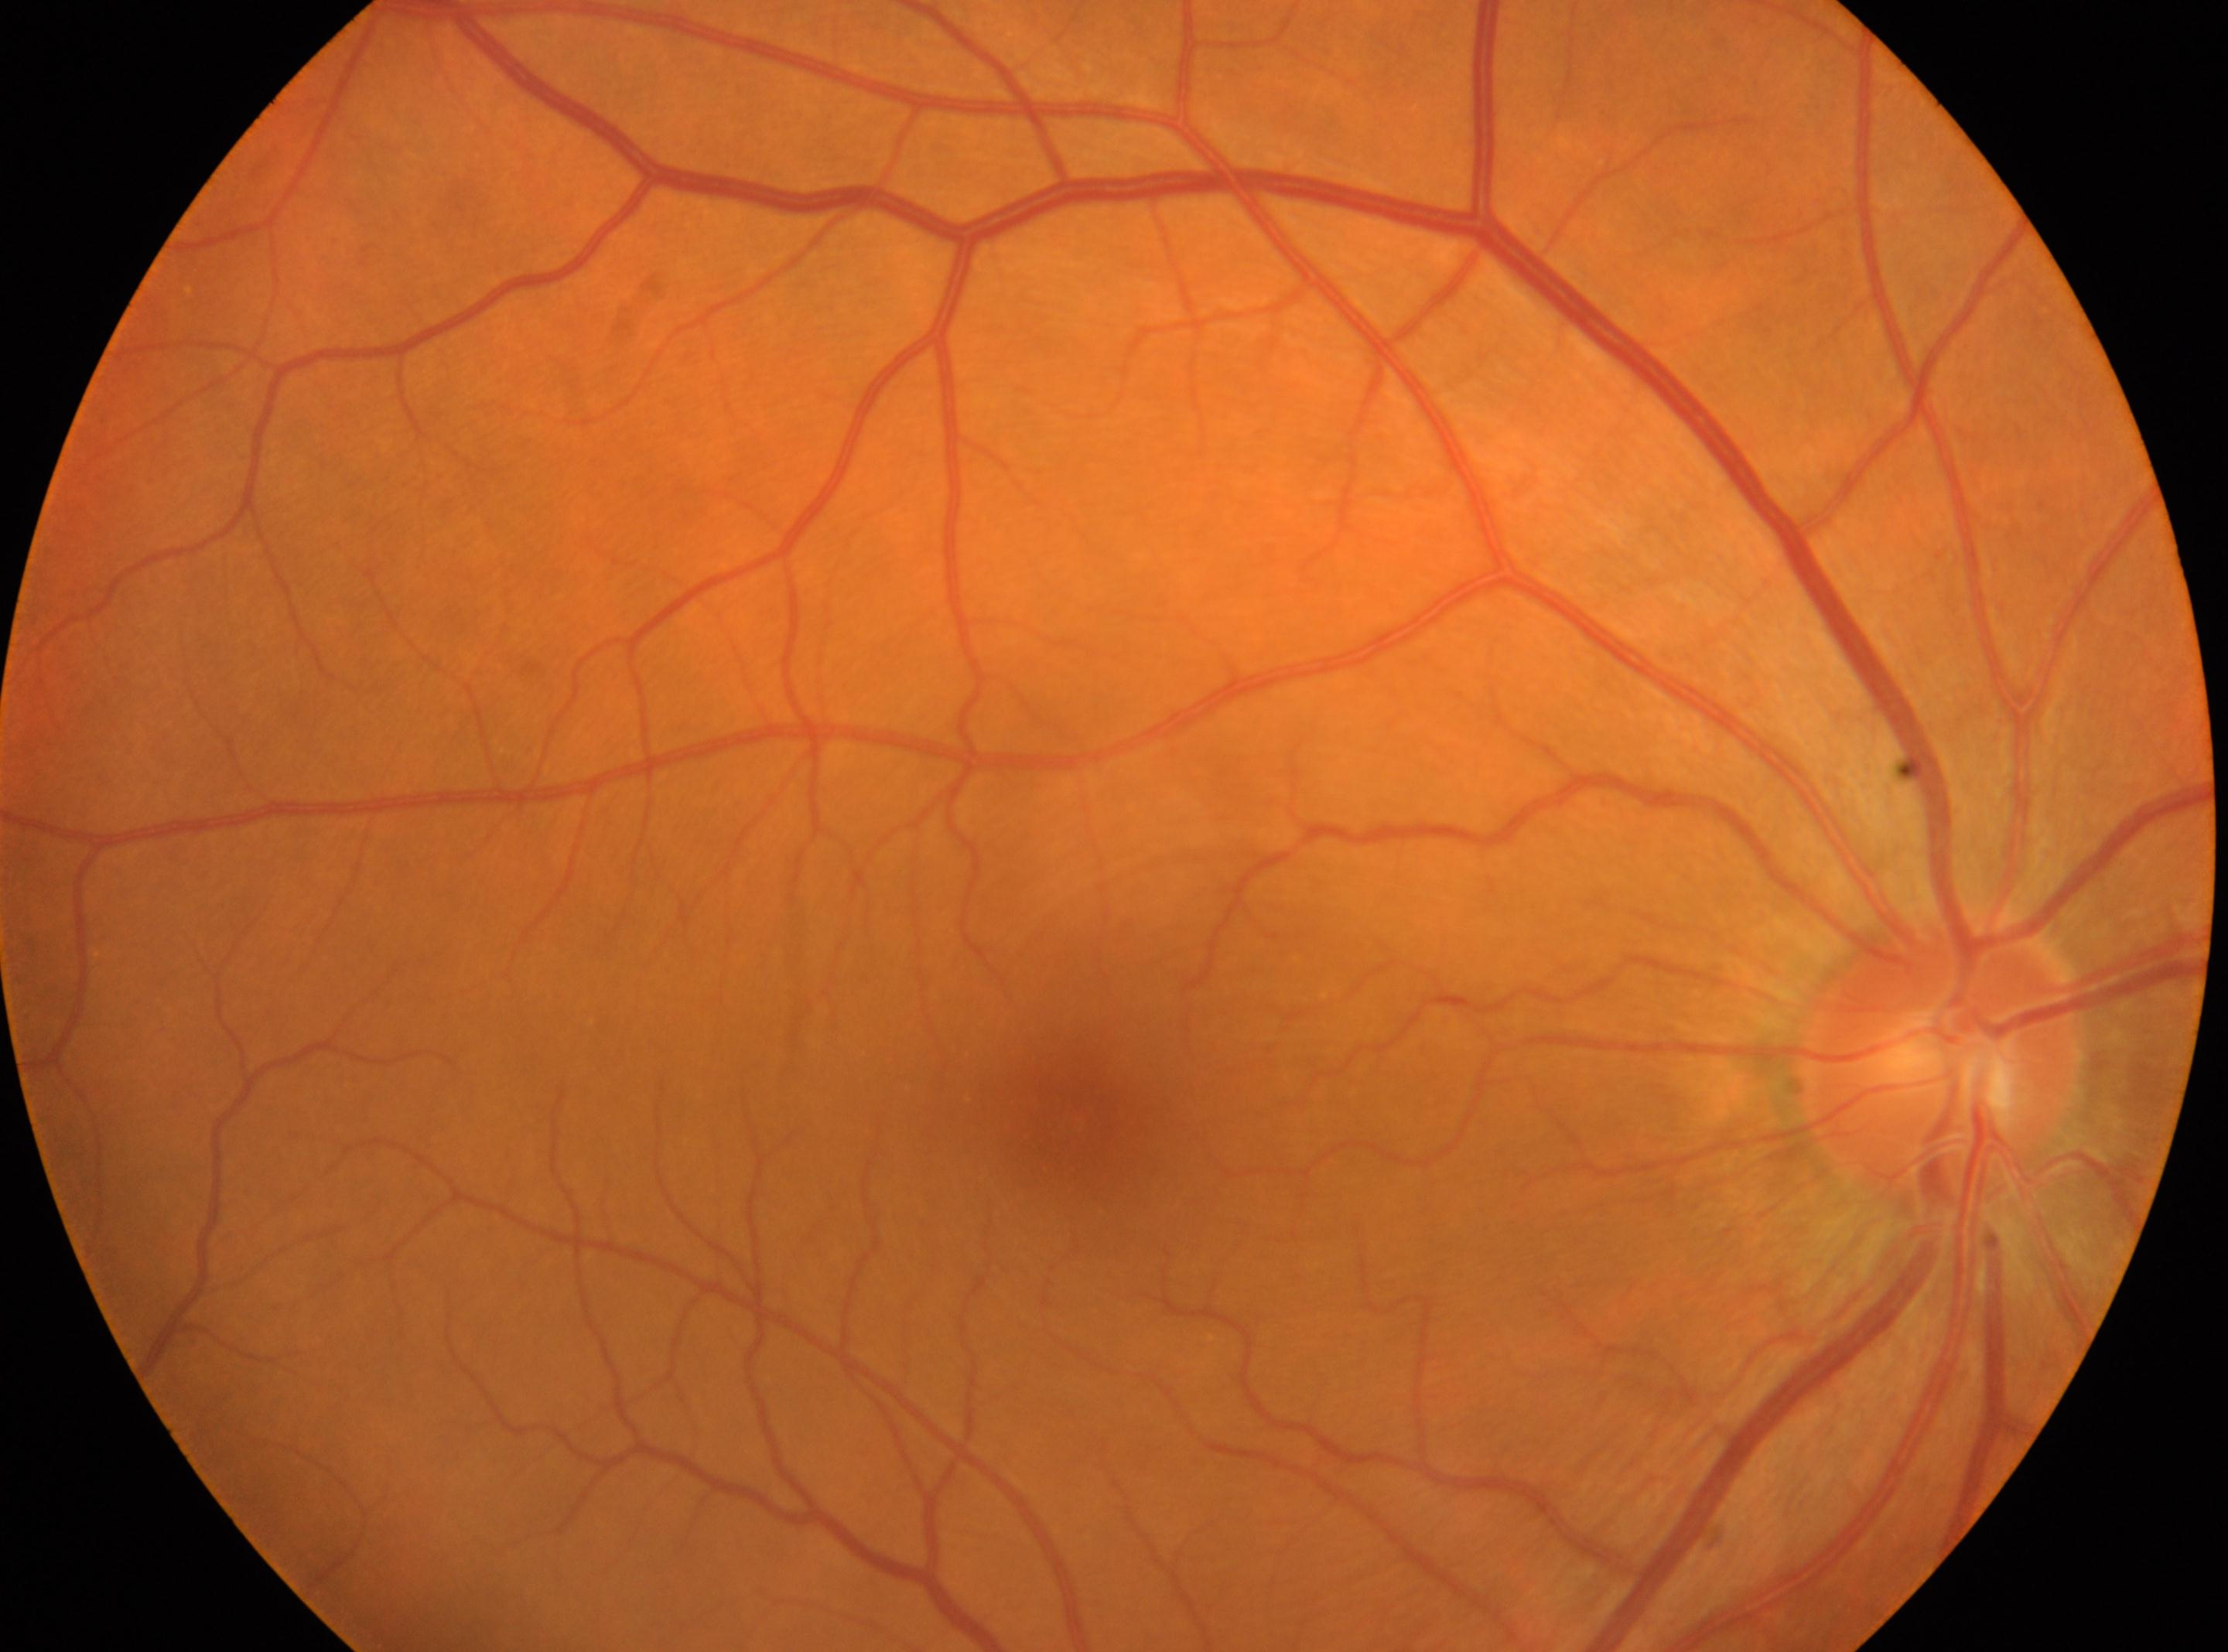

optic disk: (x: 1940, y: 1061) | macula center: (x: 1078, y: 1120) | OD | DR severity: no apparent diabetic retinopathy (grade 0).